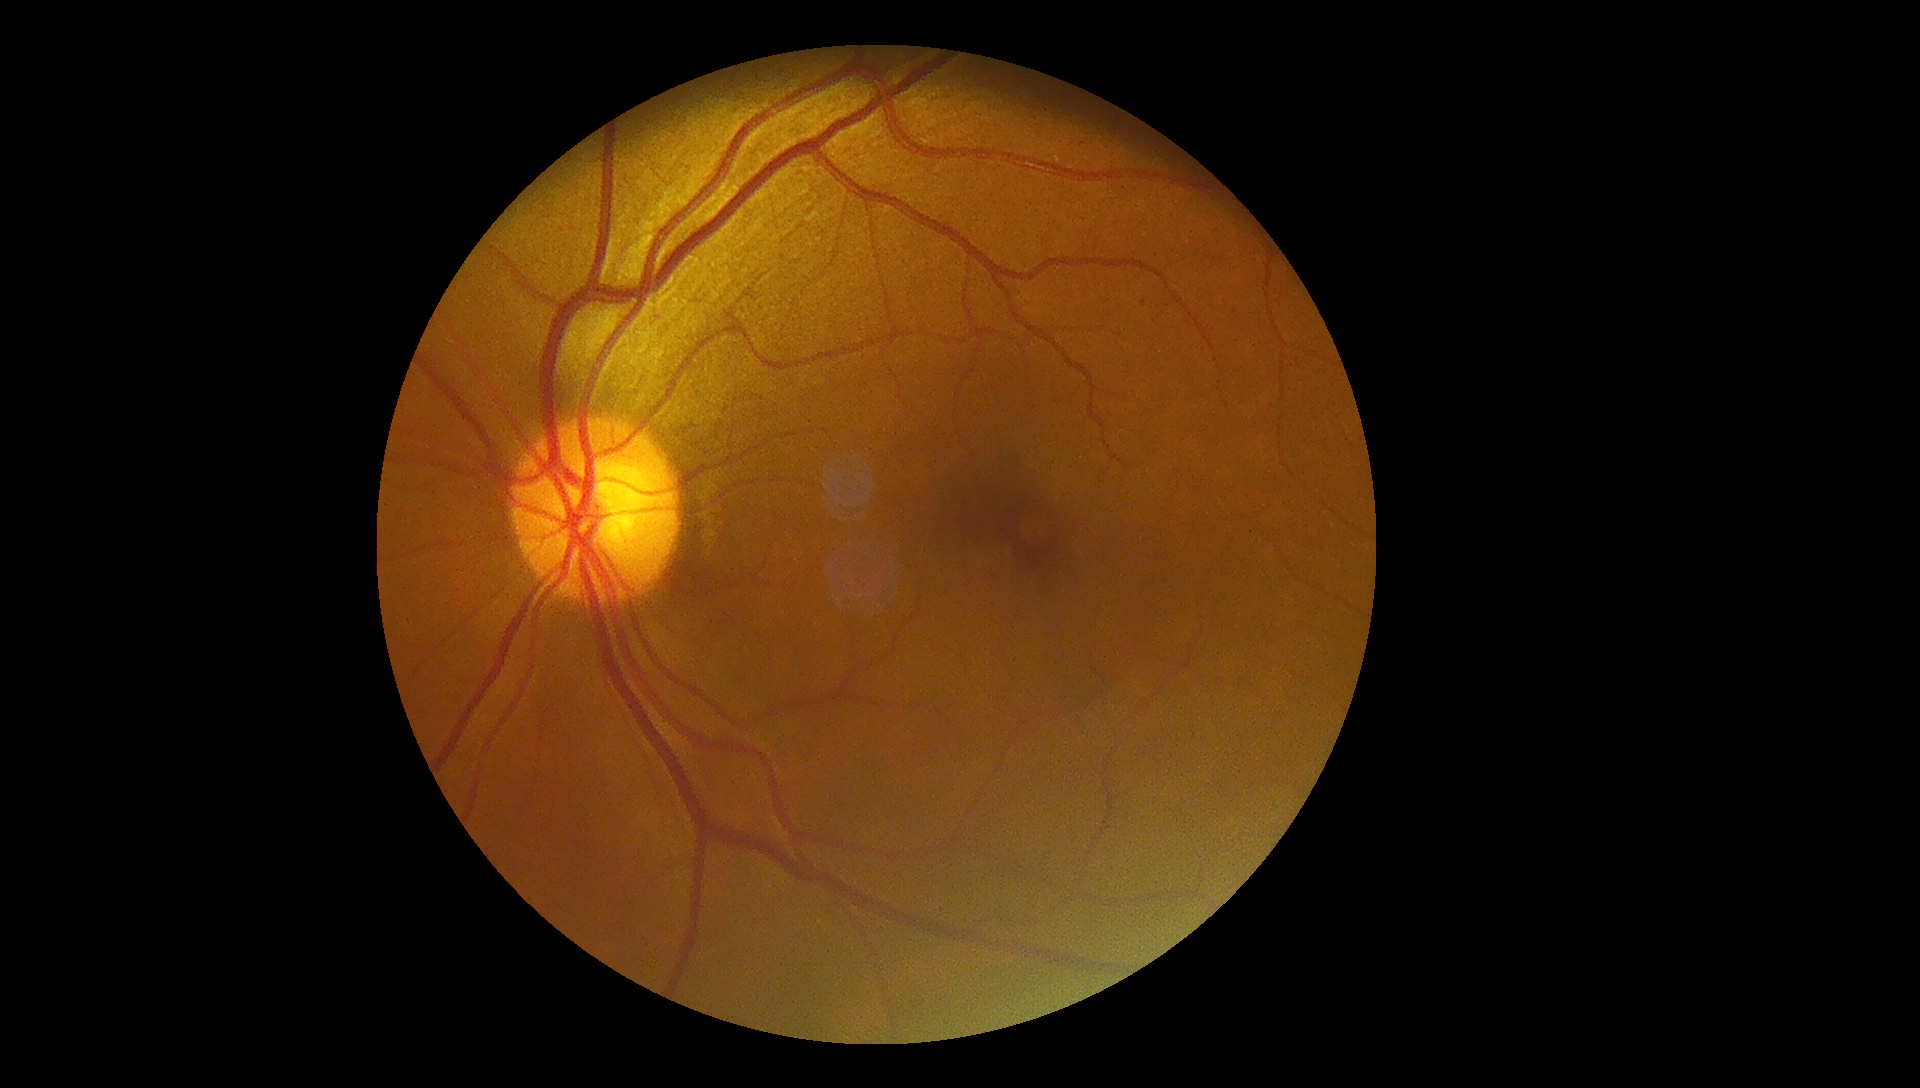
DR is mild non-proliferative diabetic retinopathy (grade 1).